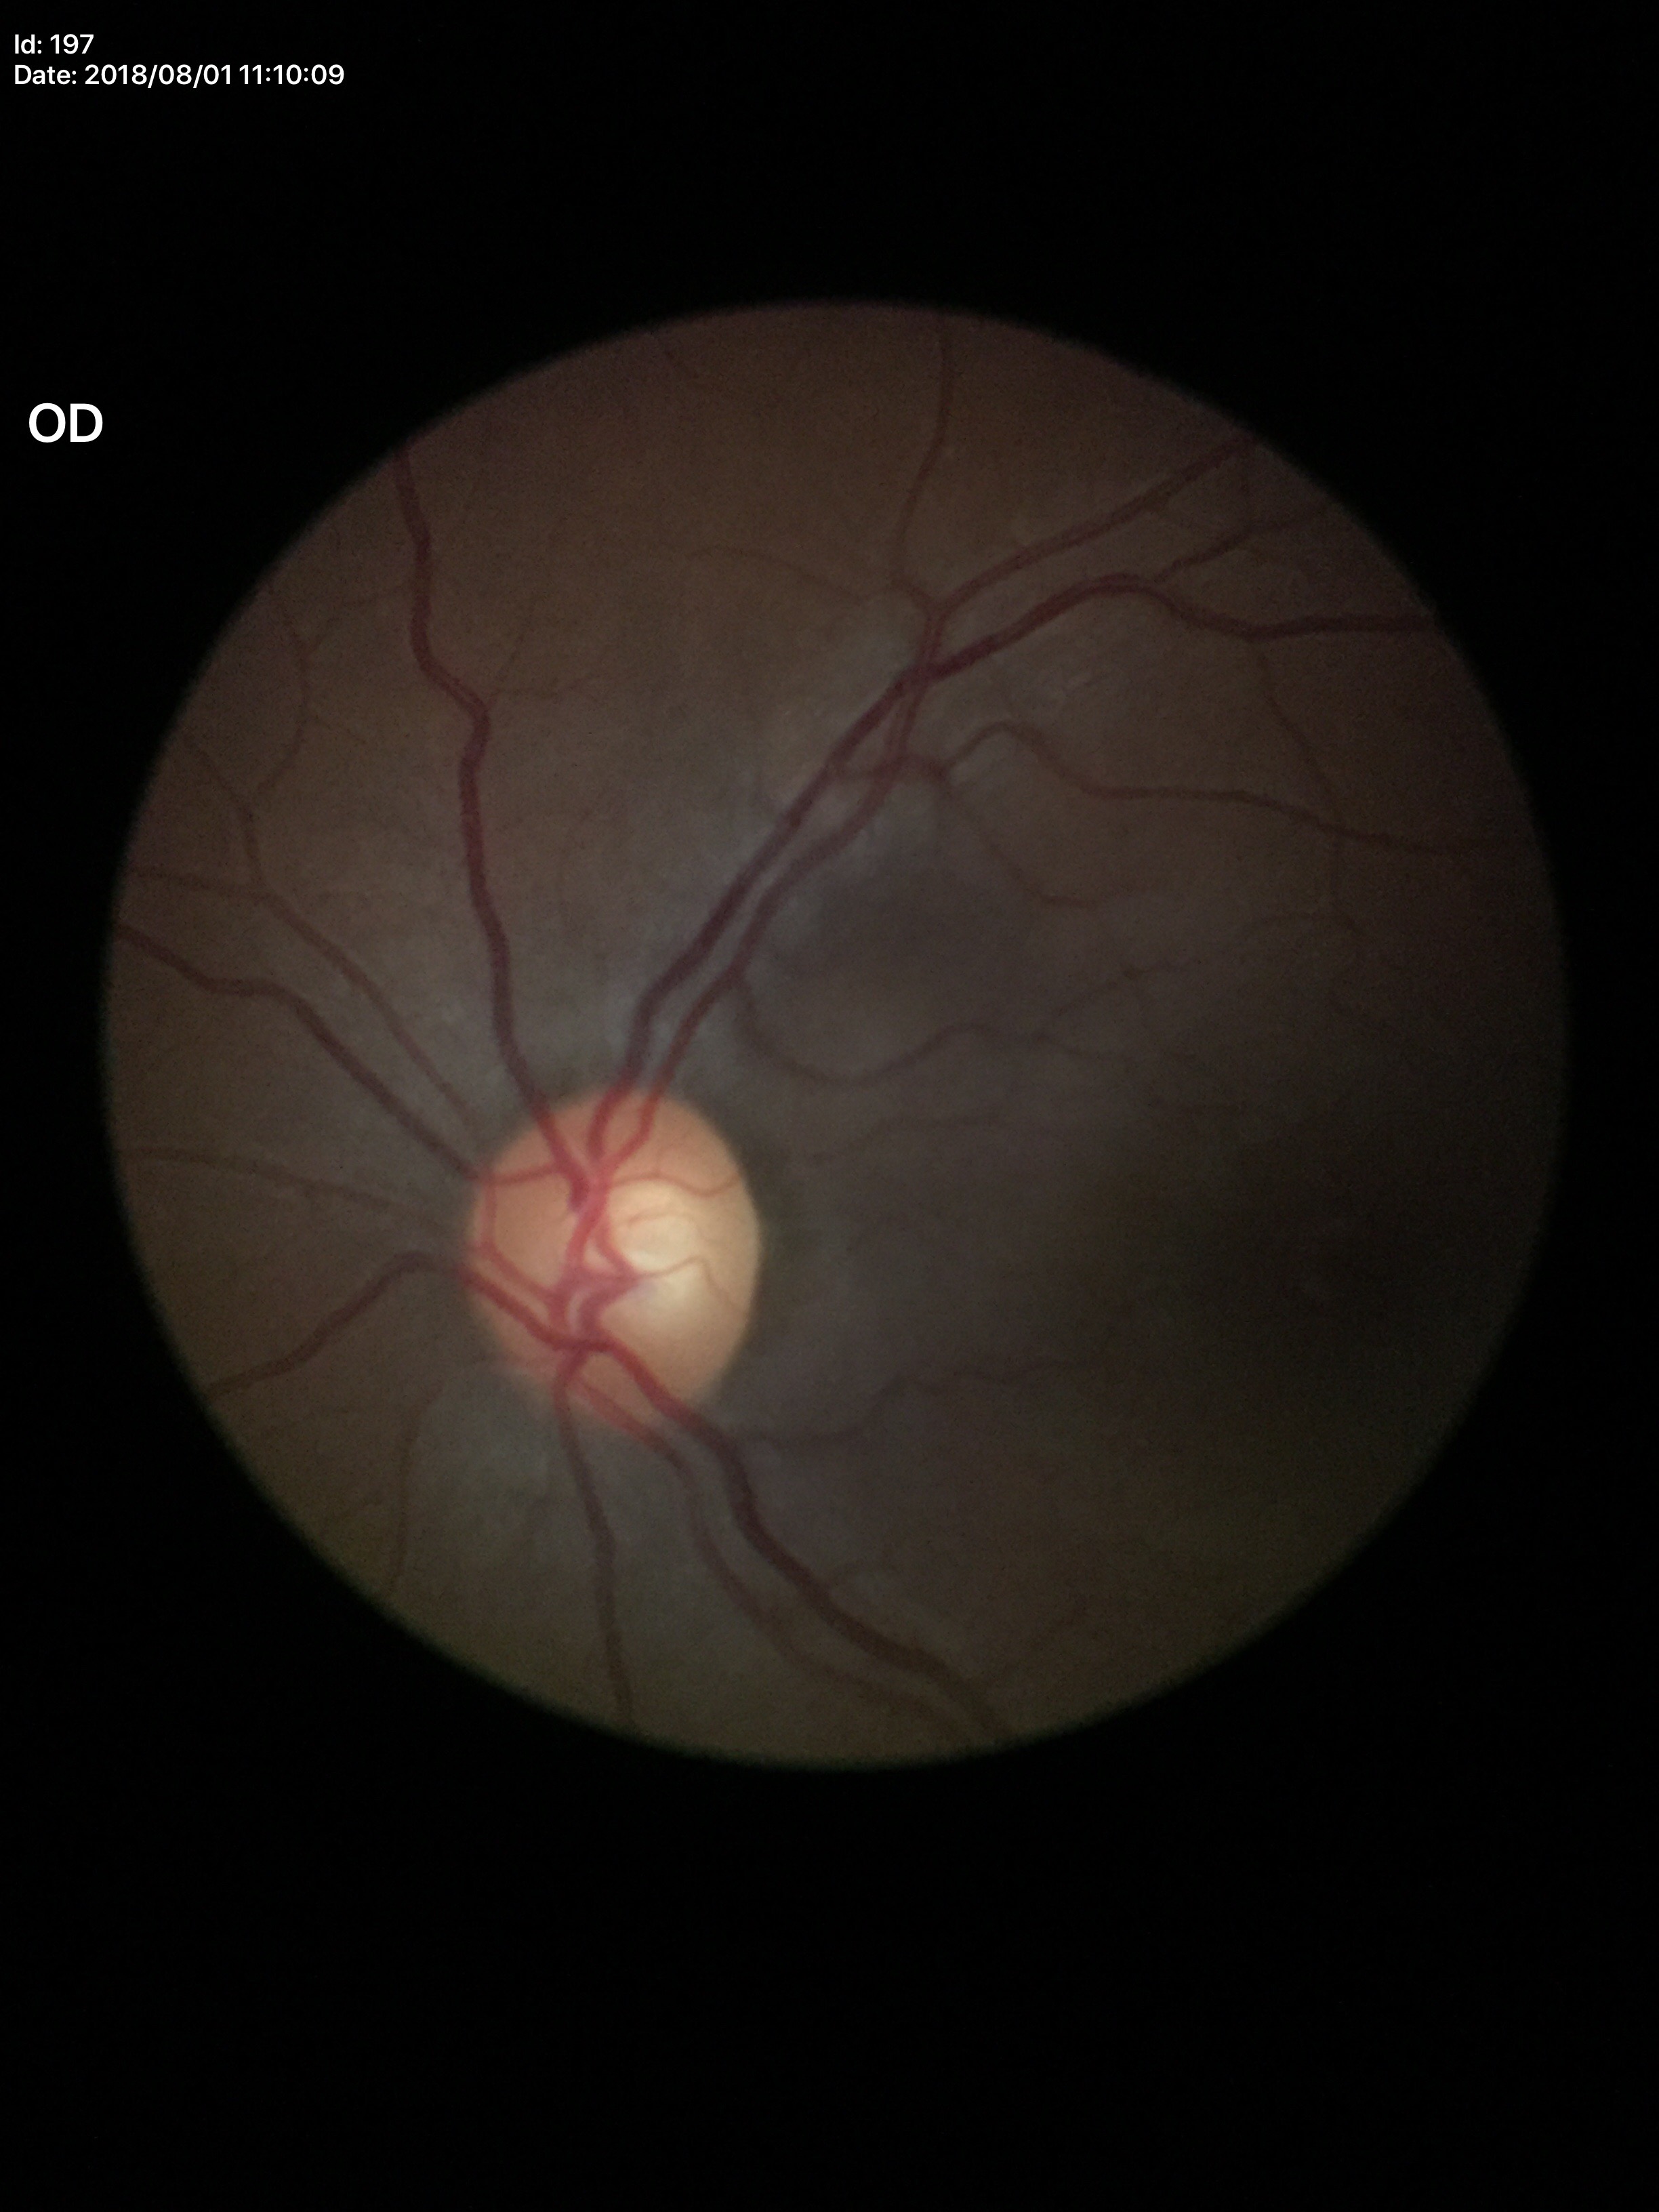
Glaucoma decision = not suspect | horizontal cup-disc ratio (HCDR) = 0.61 | vertical C/D ratio (VCDR) = 0.52.